Color fundus image — 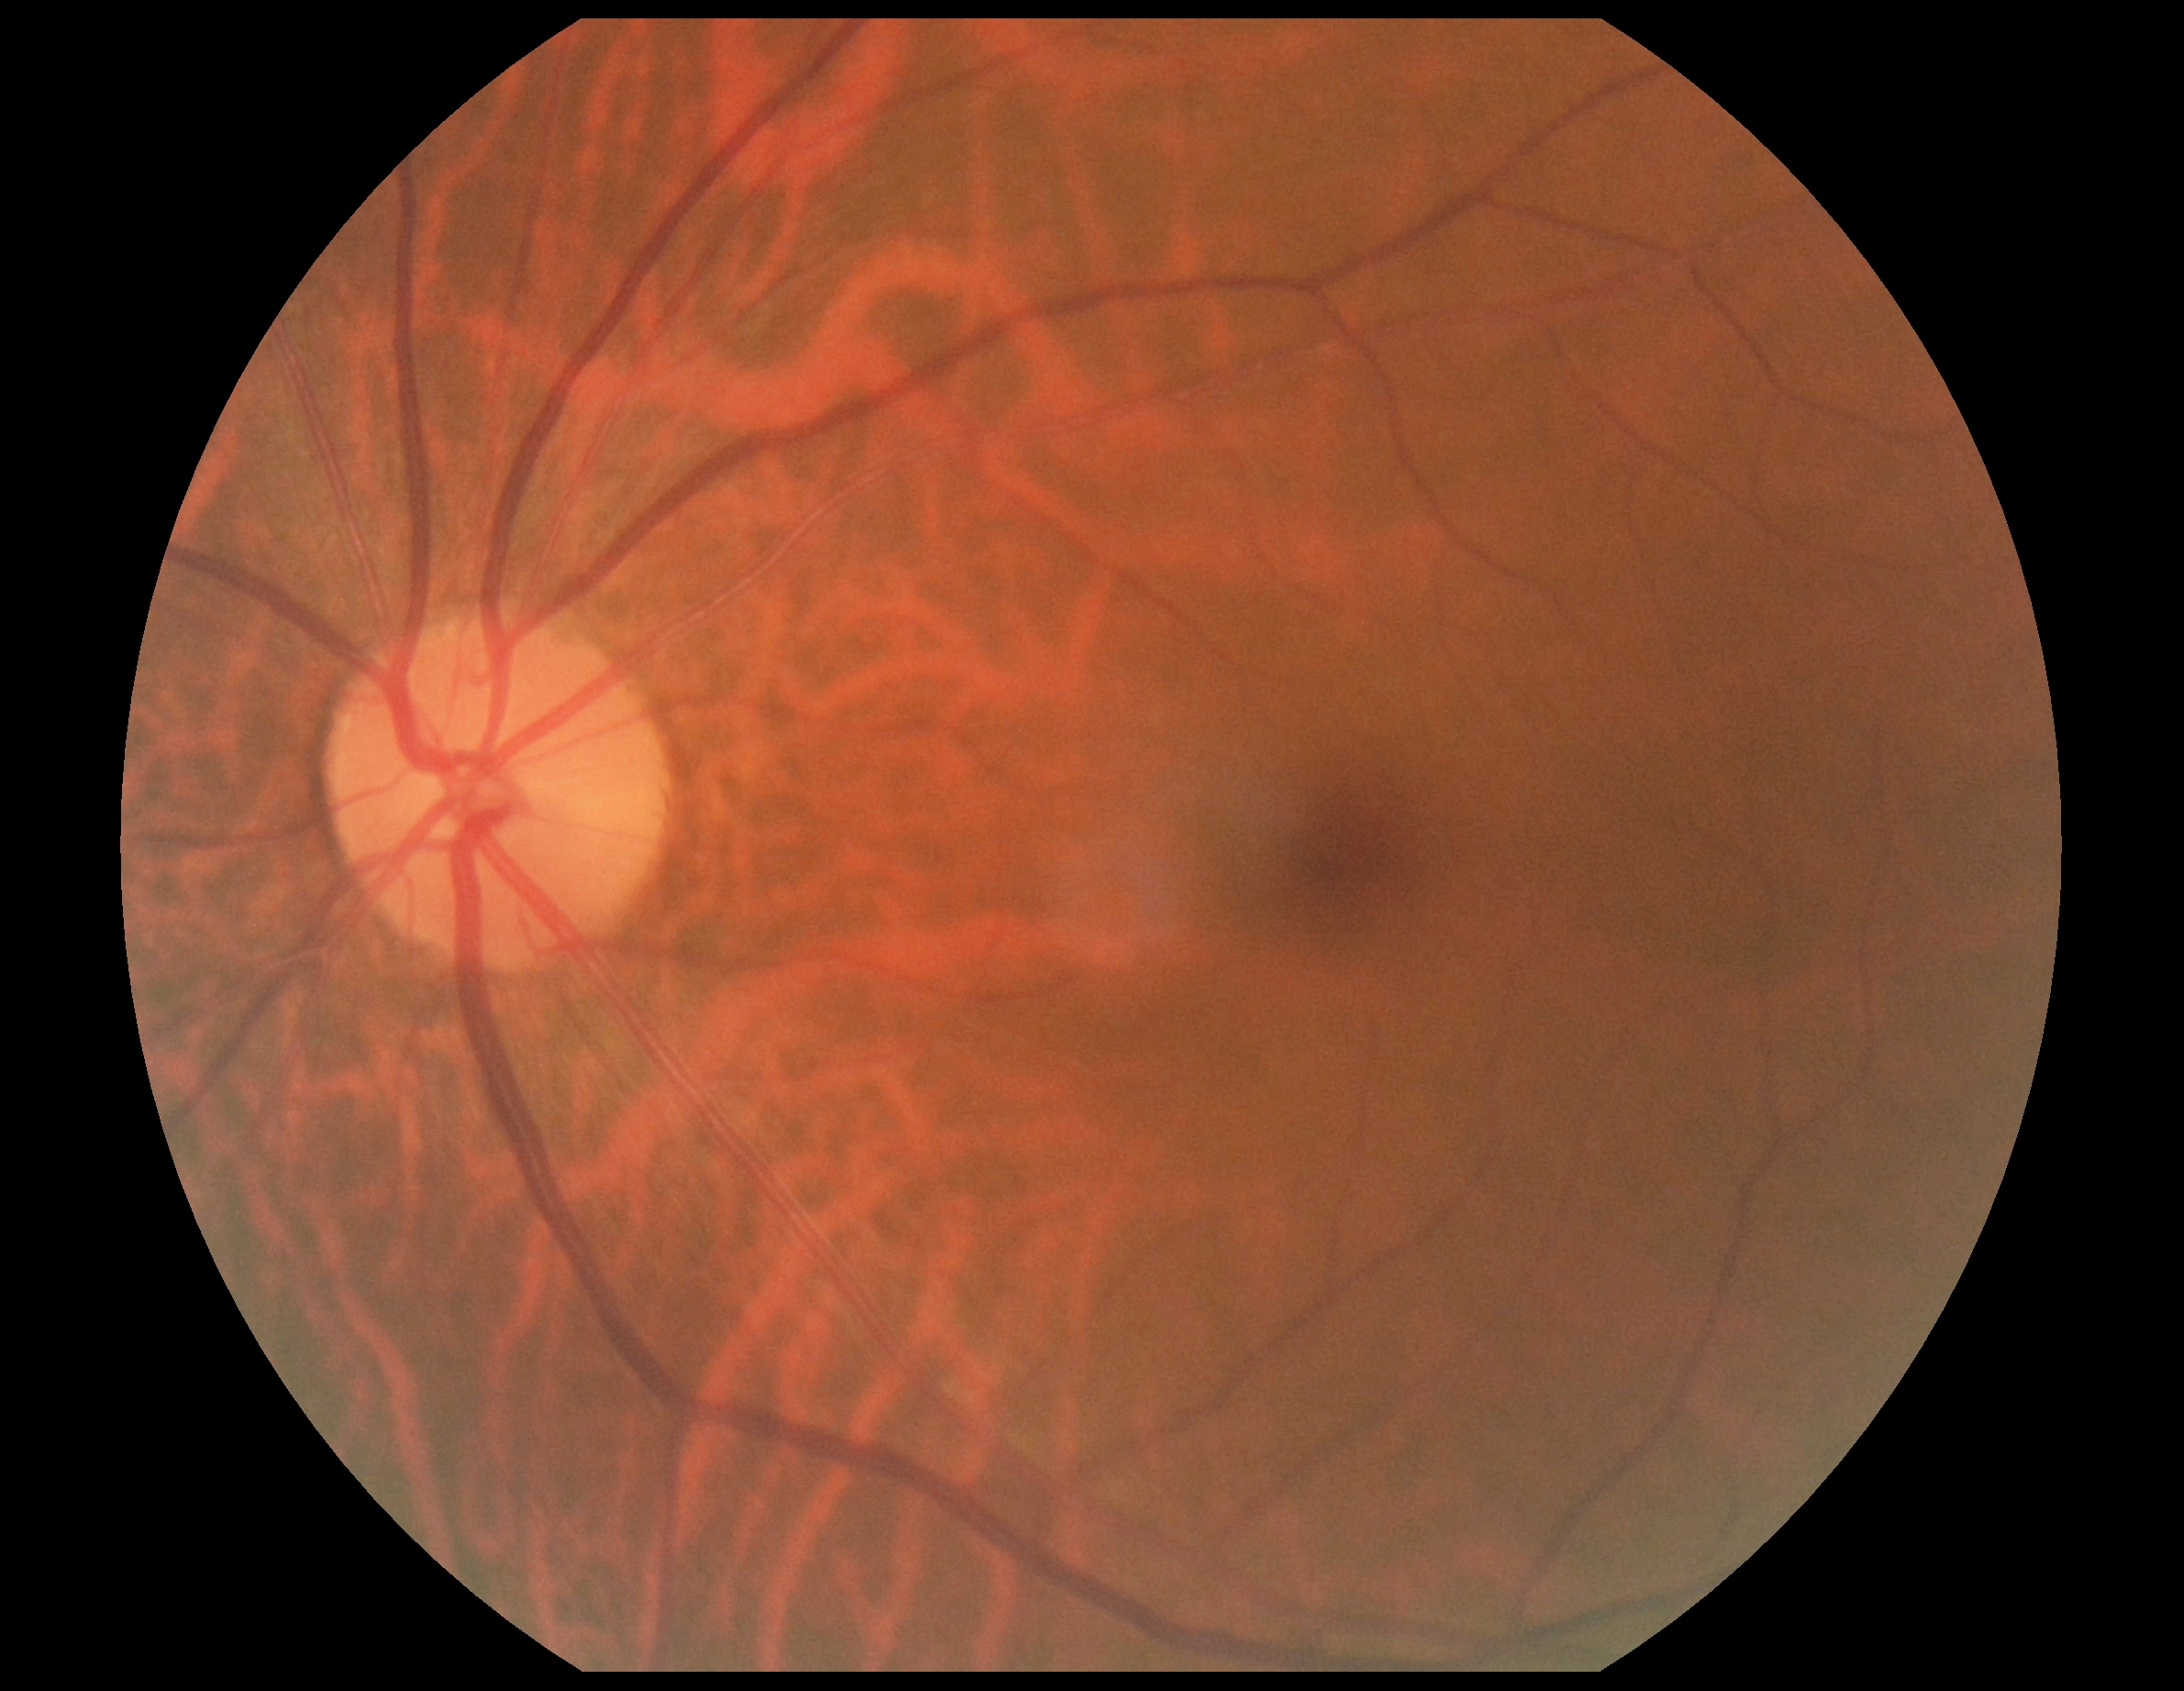

Diabetic retinopathy: 0/4 — no visible signs of diabetic retinopathy.
No DR findings.